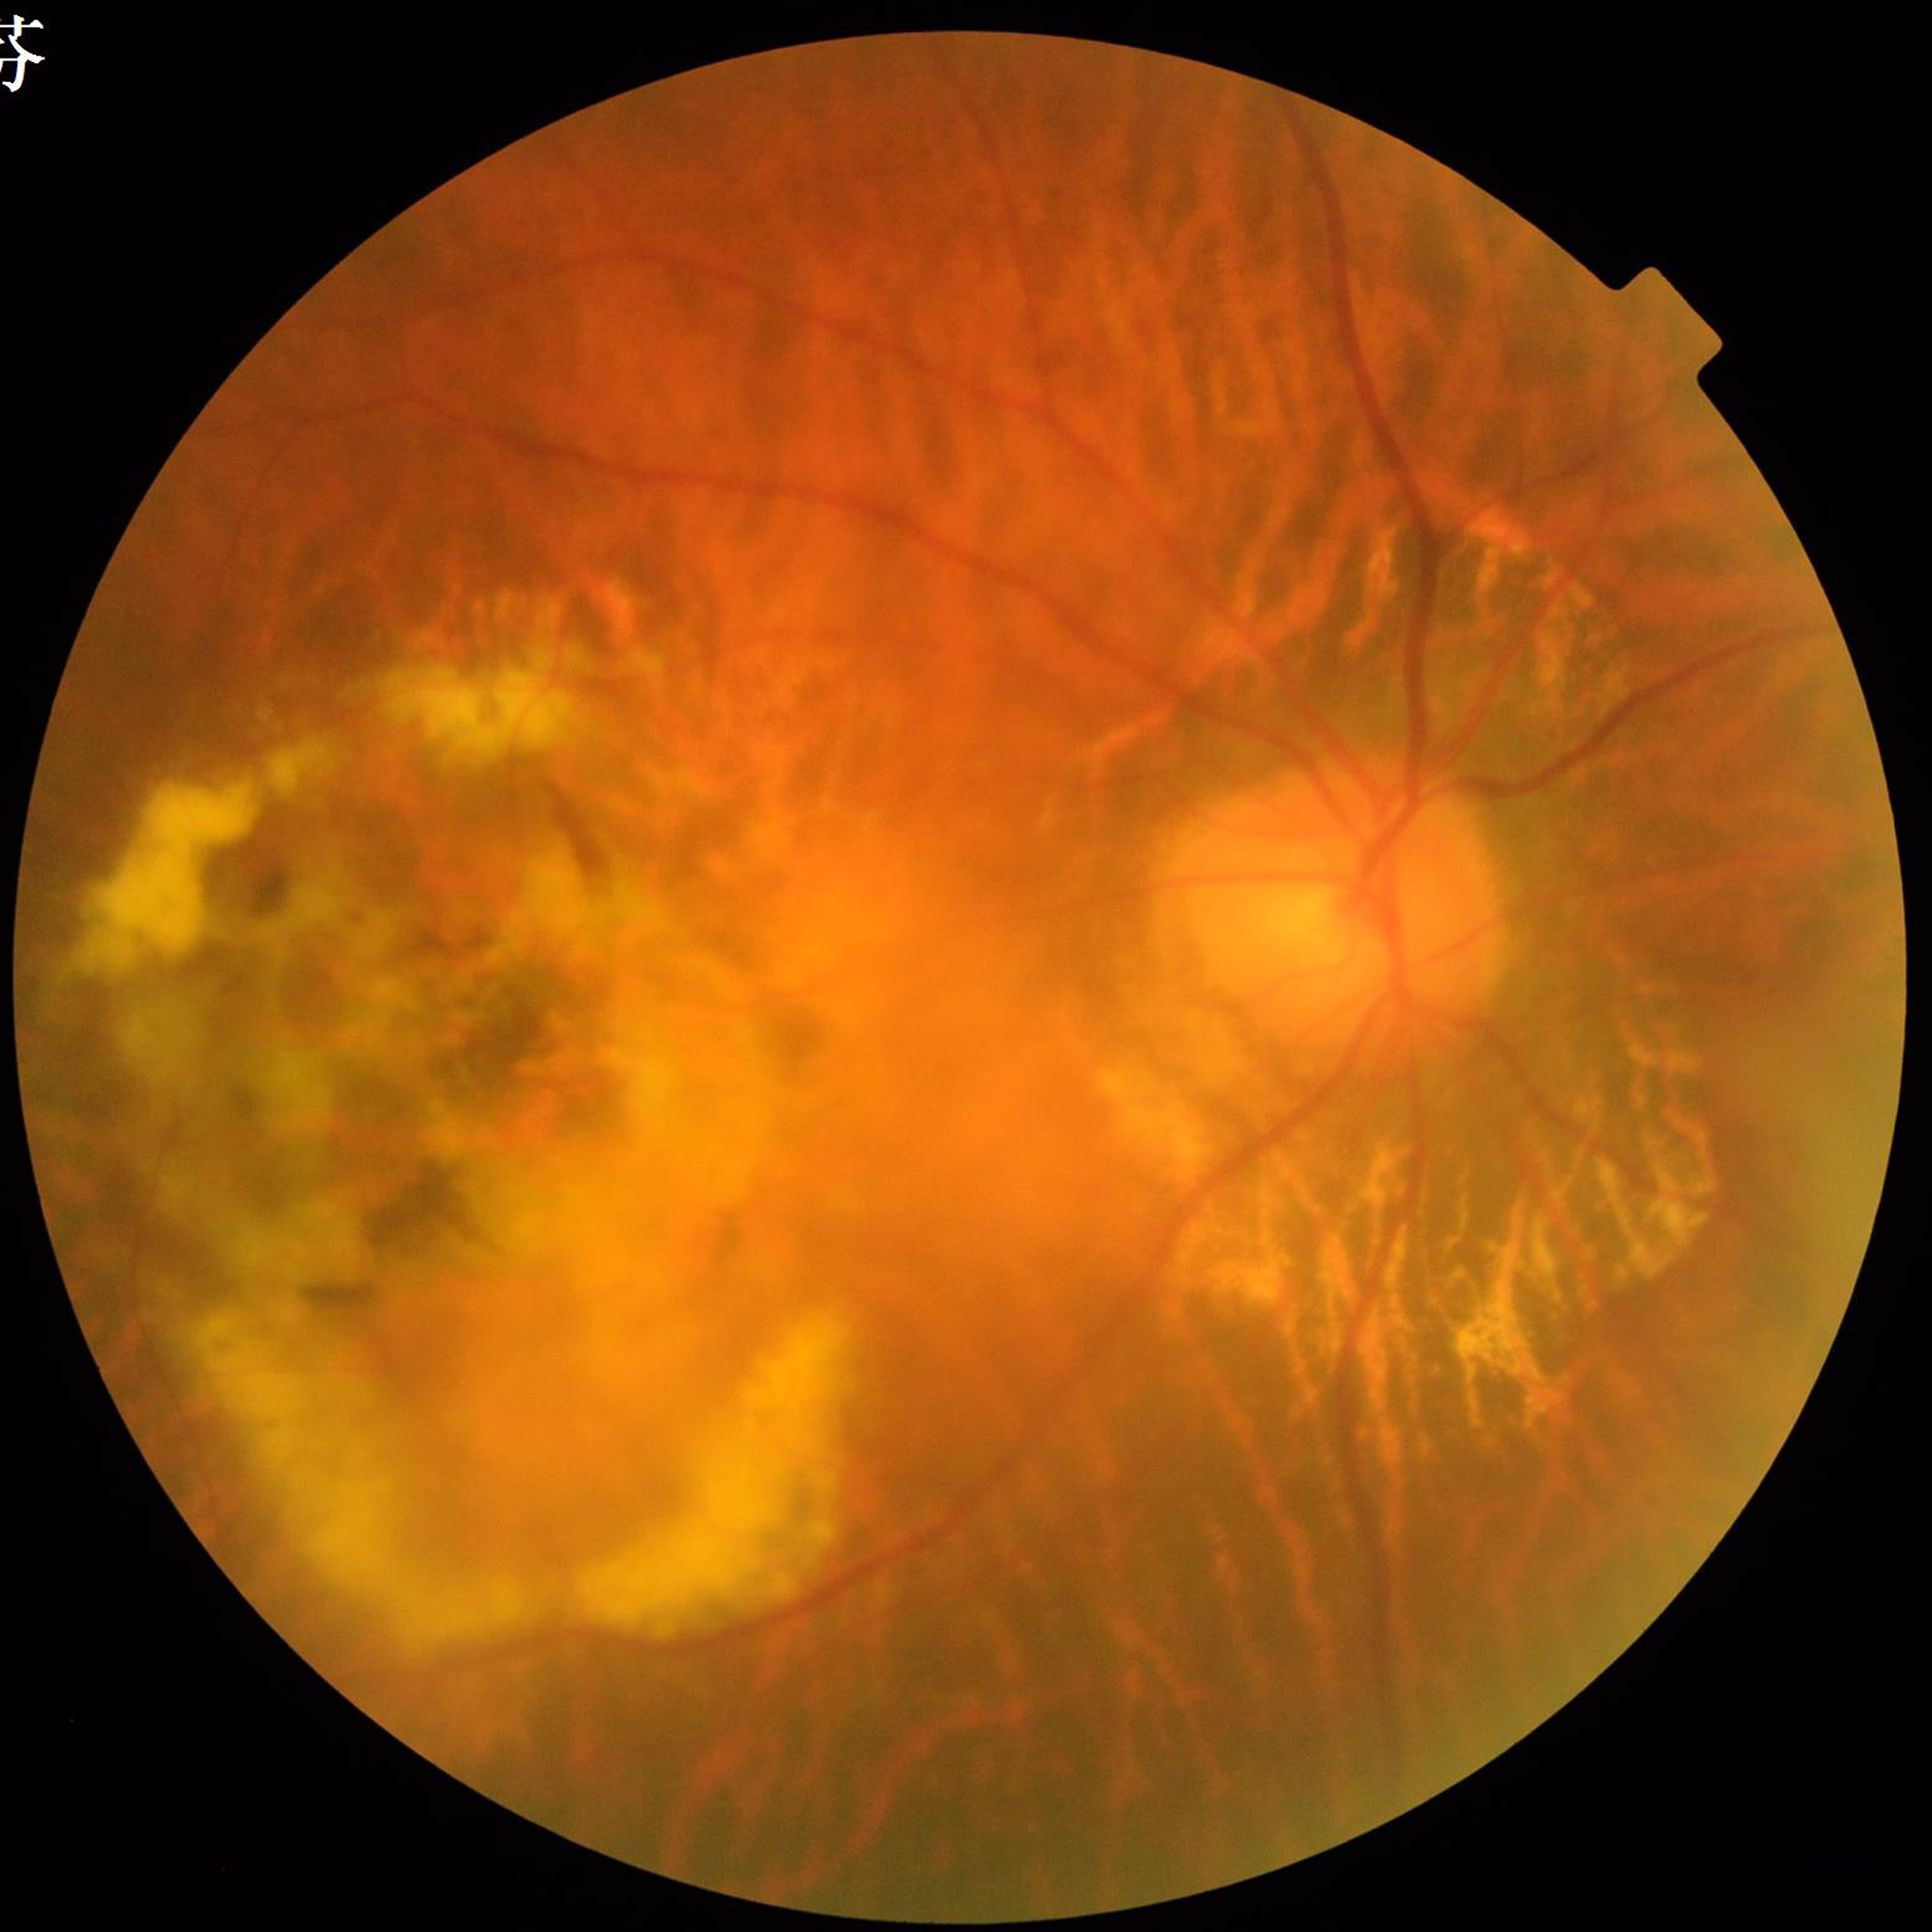

Photo quality = reduced — blur | Impression = AMD.